2212 by 1659 pixels · FOV: 45 degrees
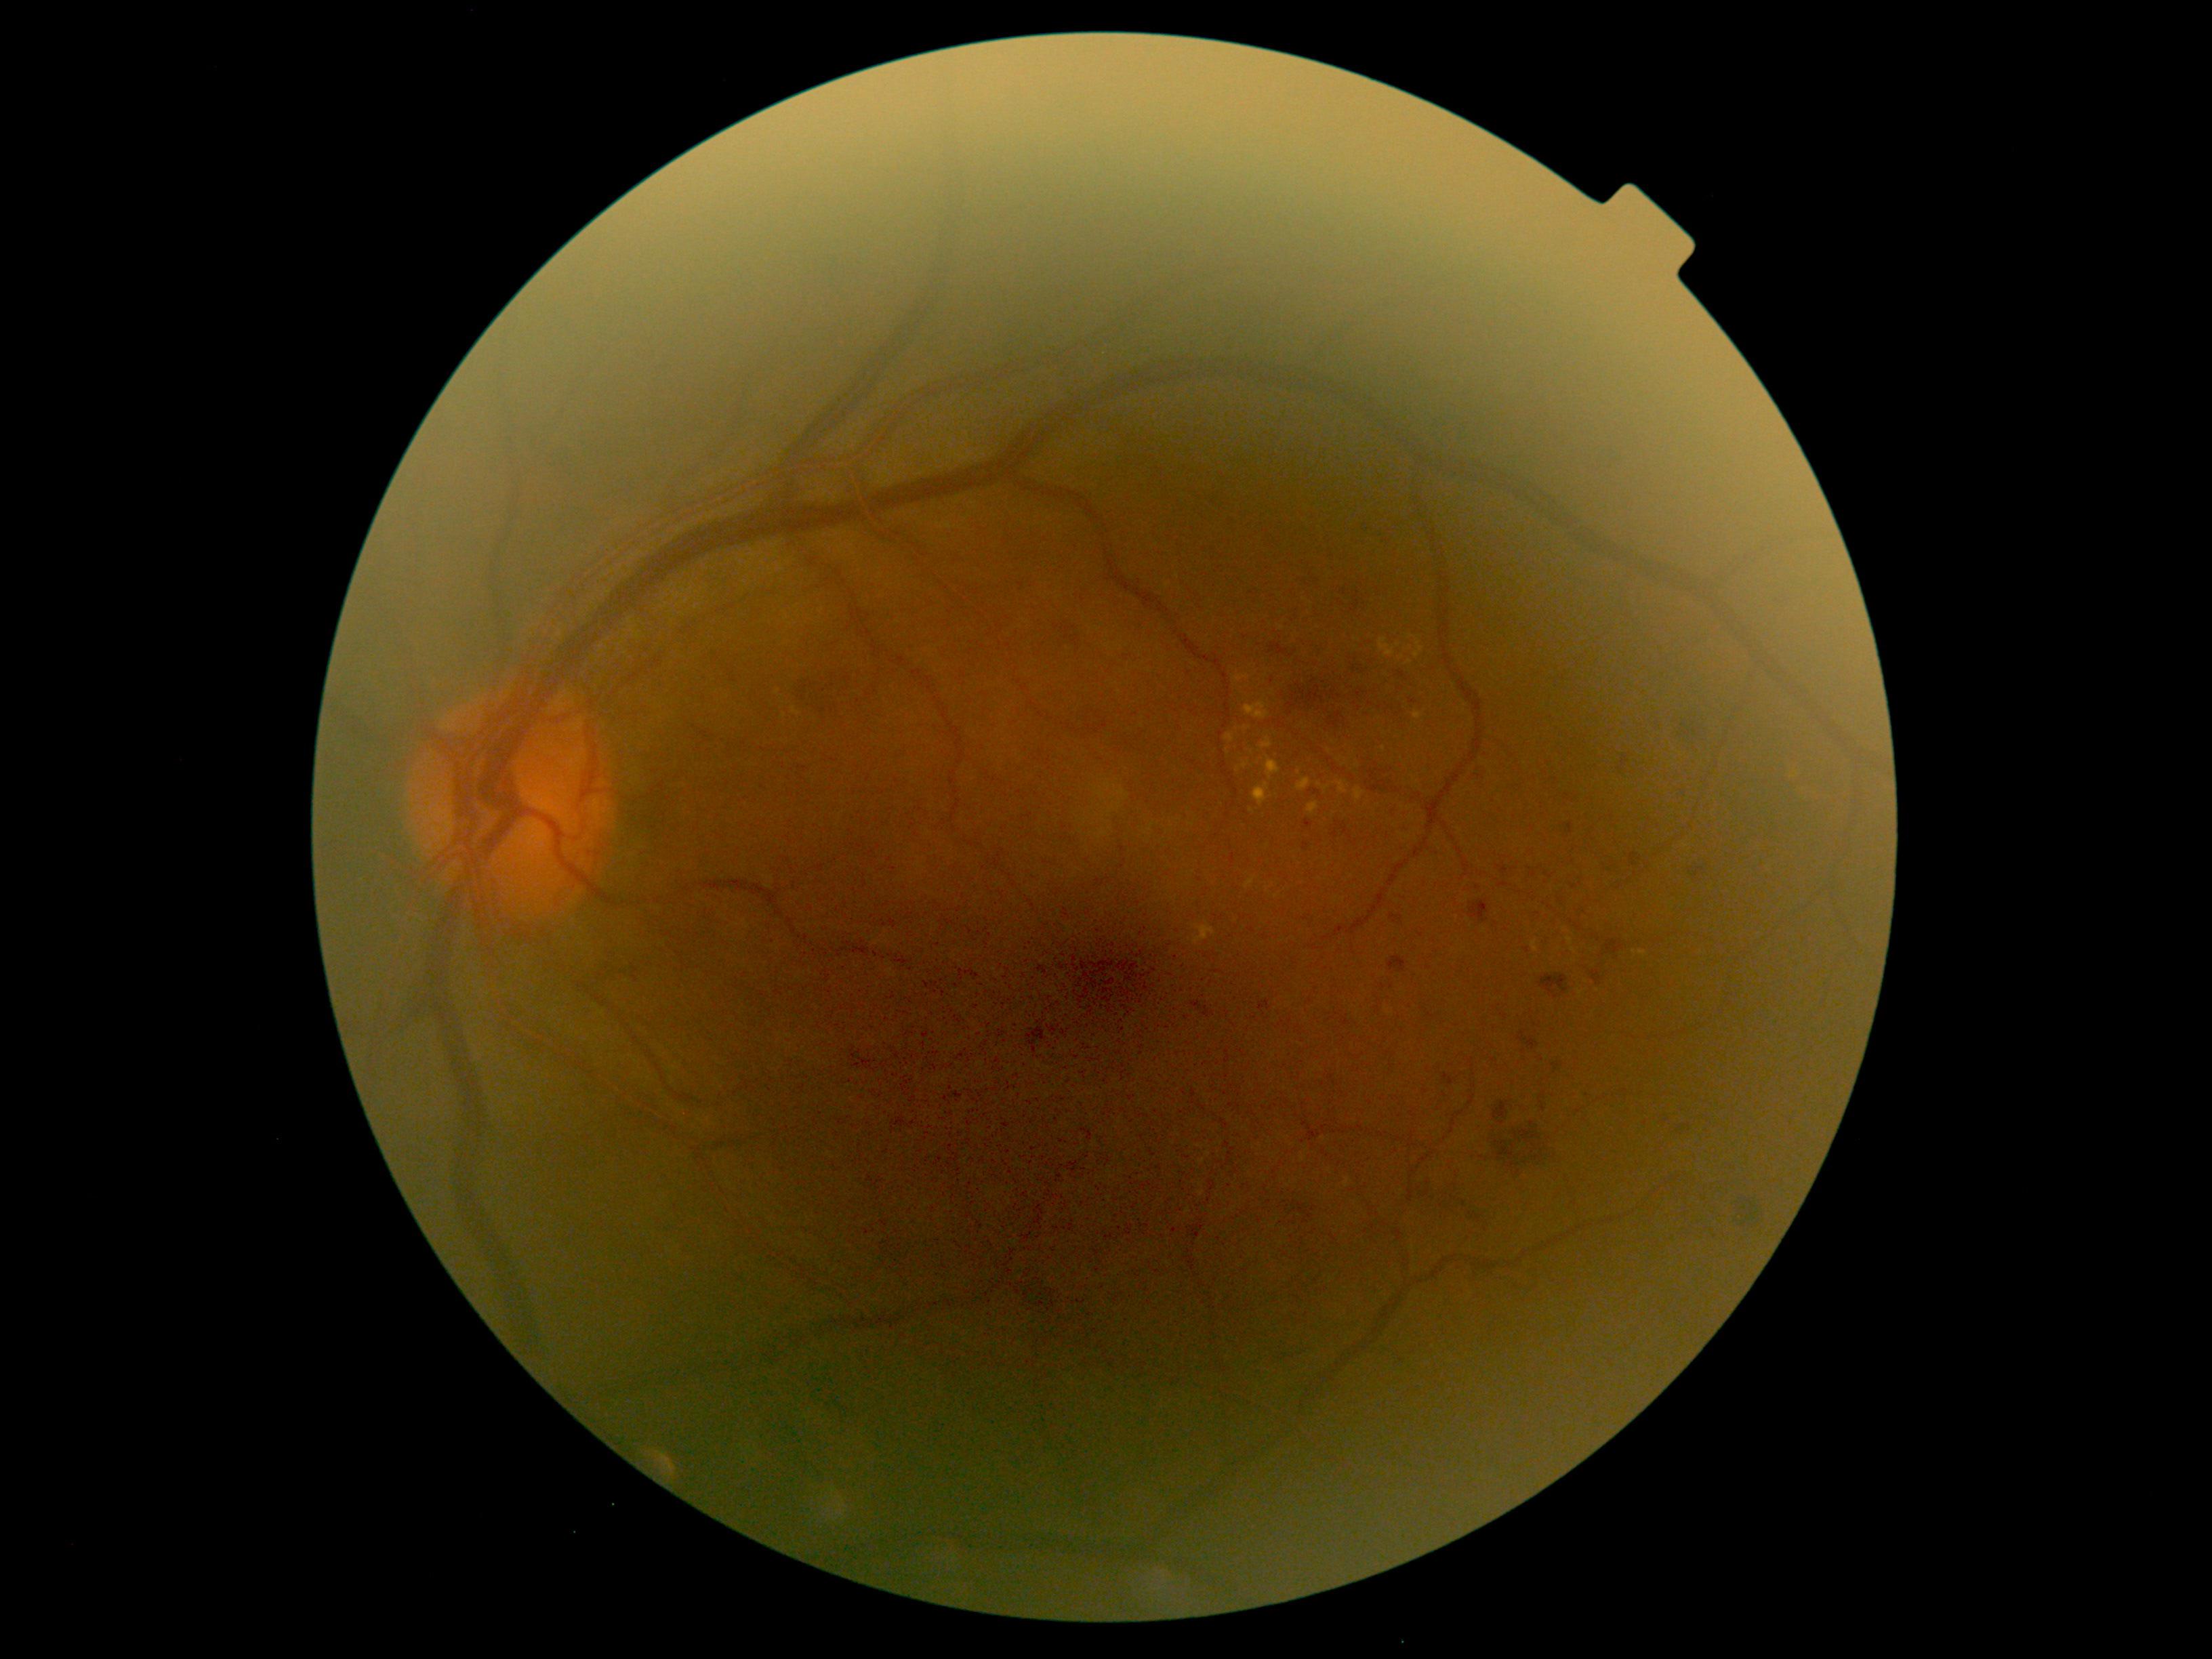 Diabetic retinopathy (DR): grade 2.